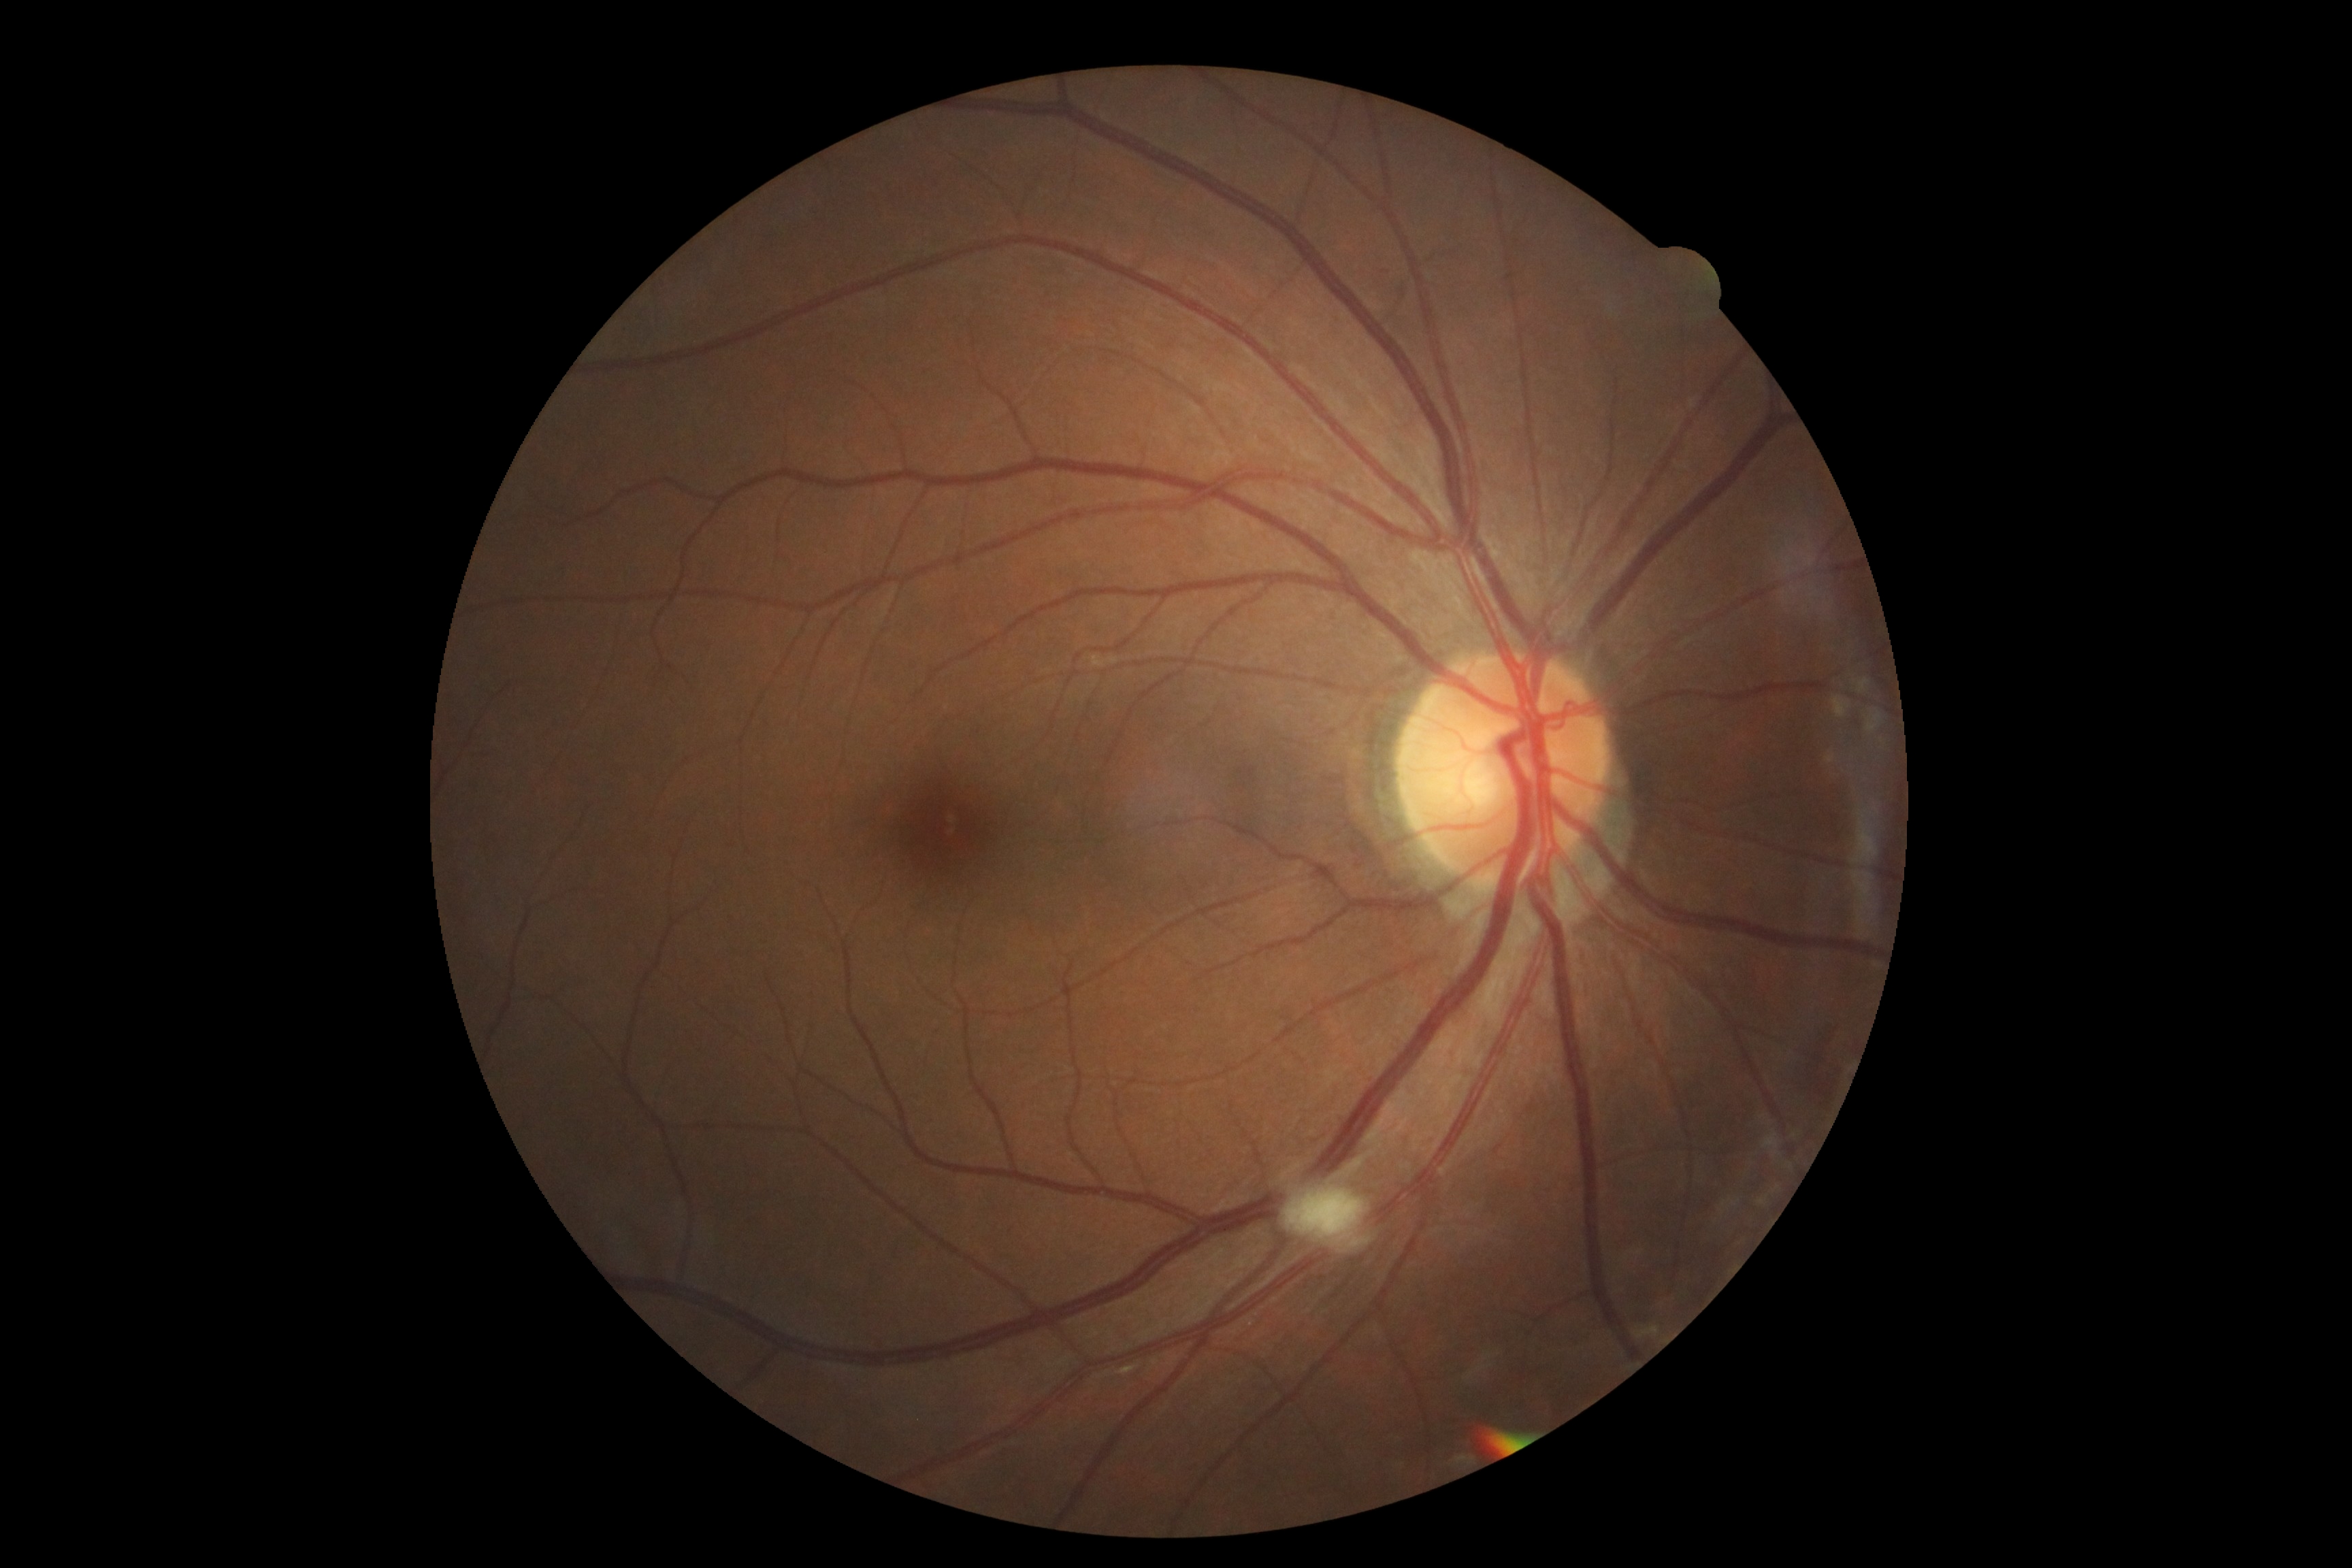

DR: grade 2 (moderate NPDR).